1659 by 2212 pixels; captured on a Remidio Fundus on Phone (FOP) camera.
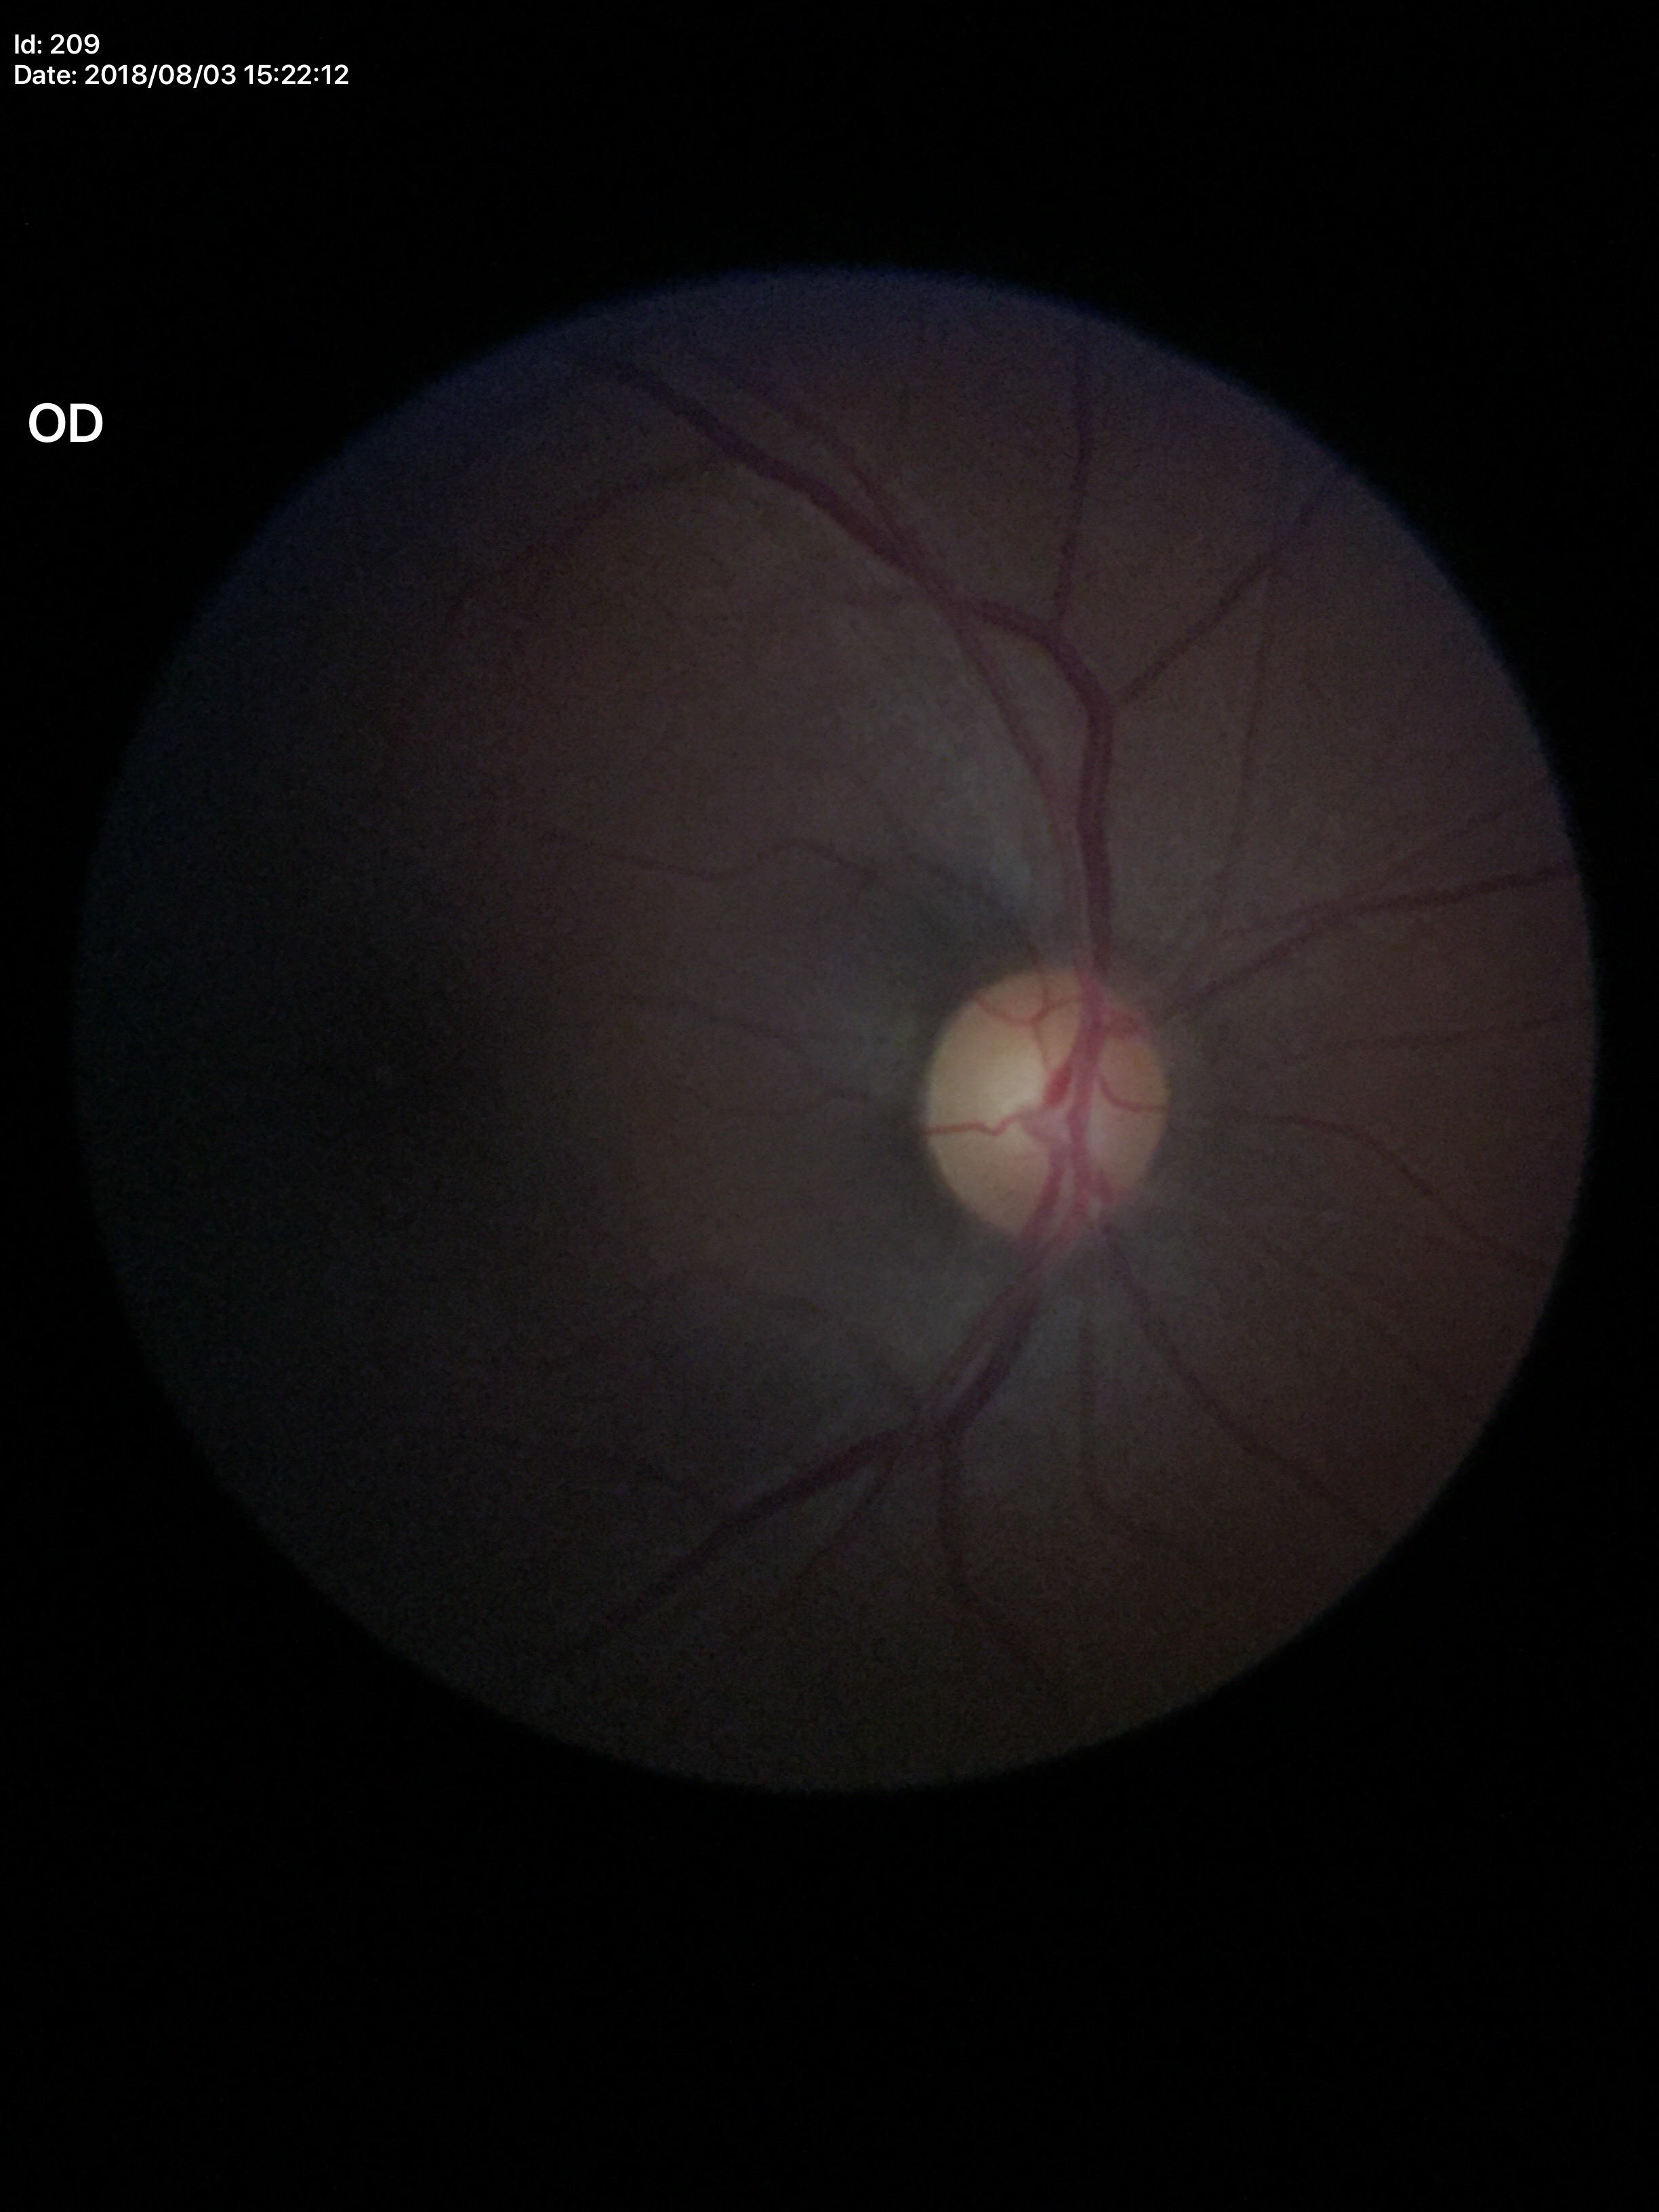
Negative for glaucoma suspicion.
Vertical cup-disc ratio (VCDR): 0.52.
Horizontal CDR (HCDR): 0.52.